Undilated pupil; pachymetry 487 µm; 30° FOV; IOP: 20 mmHg; optic disc at the center of the field; axial length: 23.27 mm: 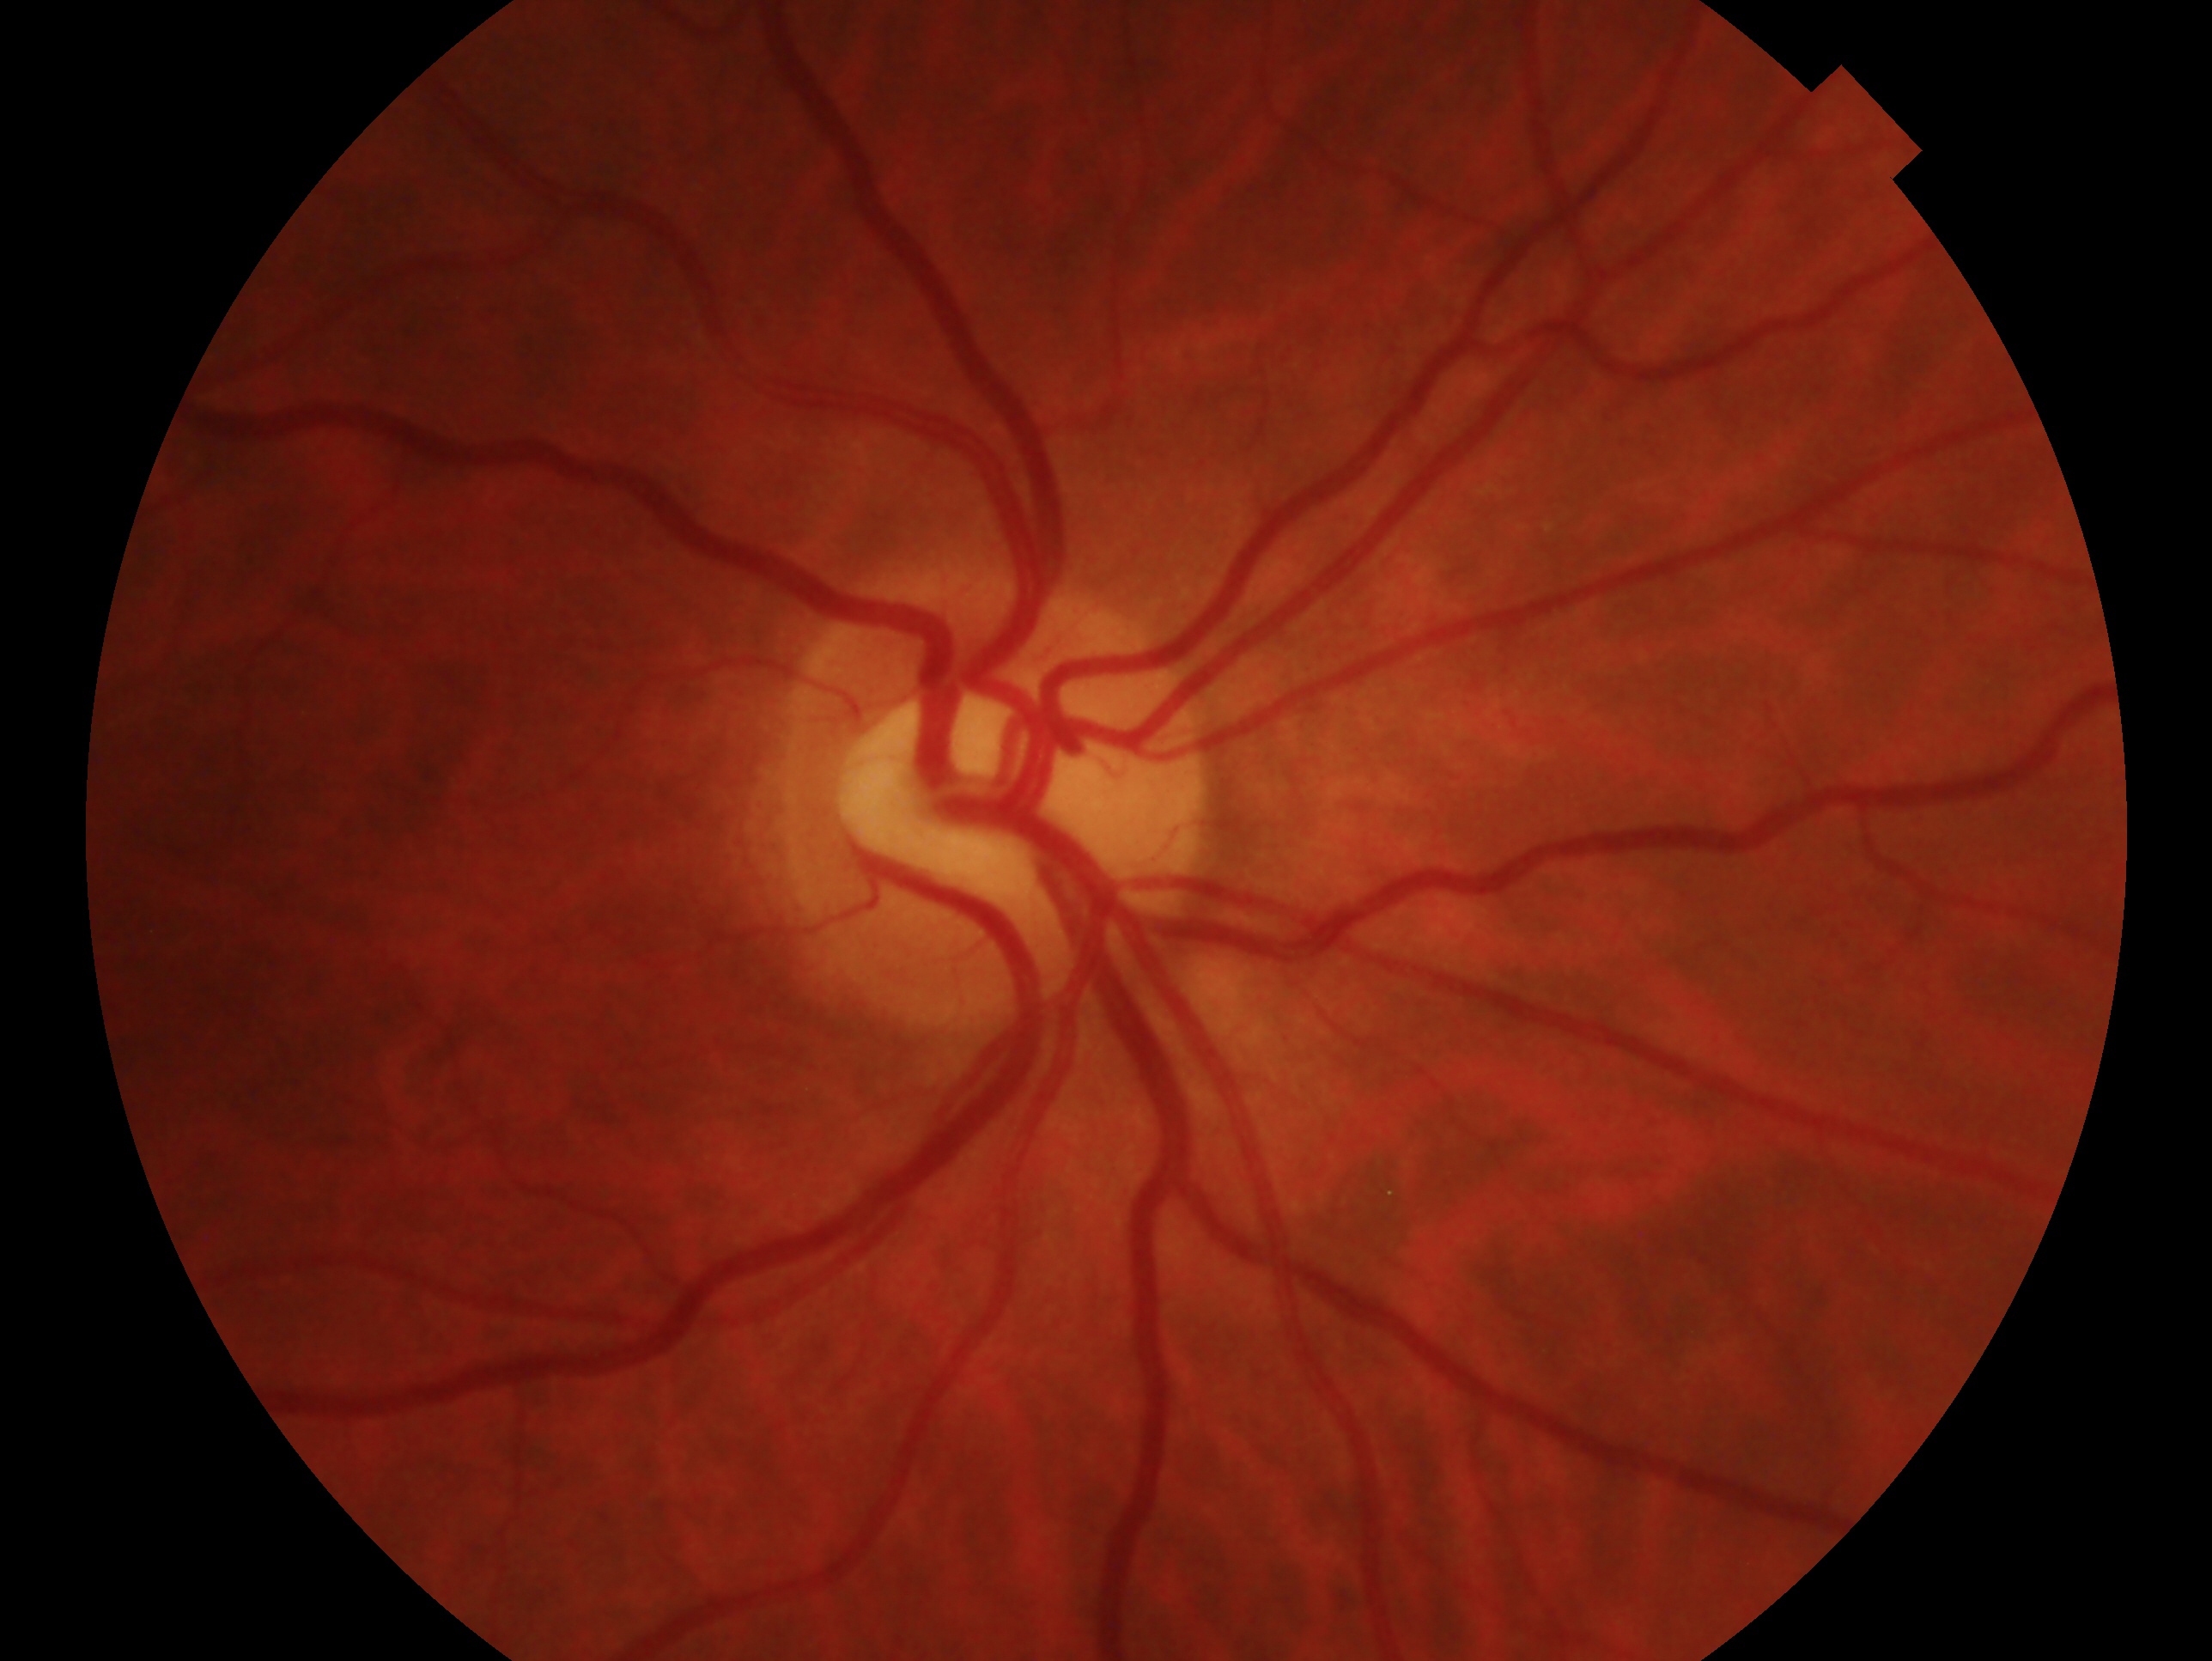

Clinical classification — no signs of glaucoma.
The image shows the OD.